Davis DR grading
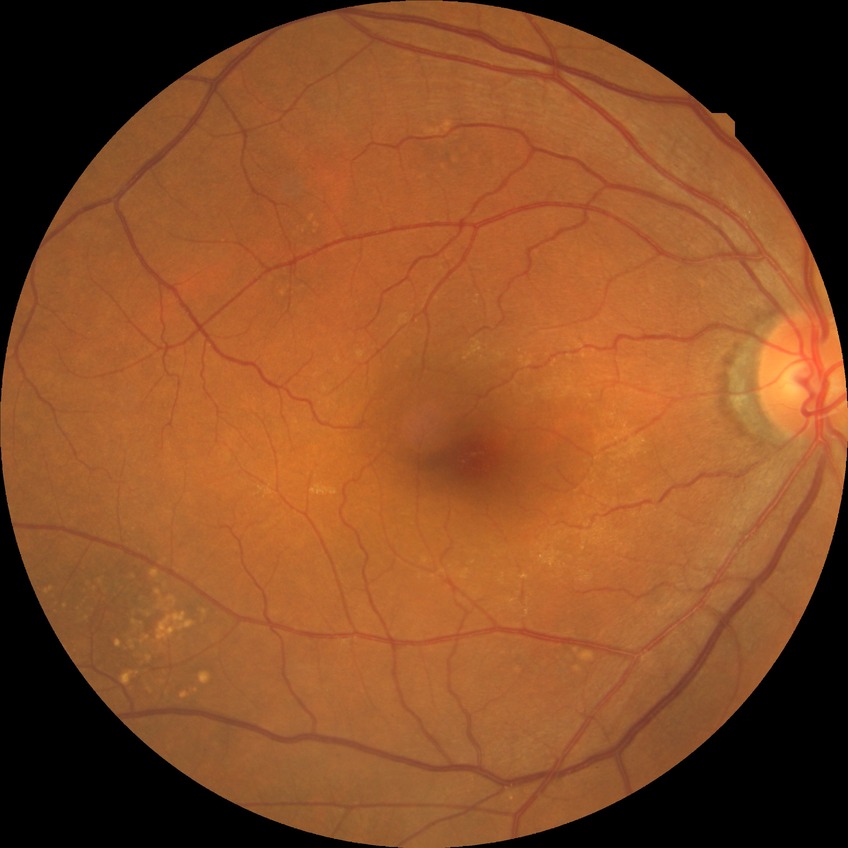 davis_grade: no diabetic retinopathy